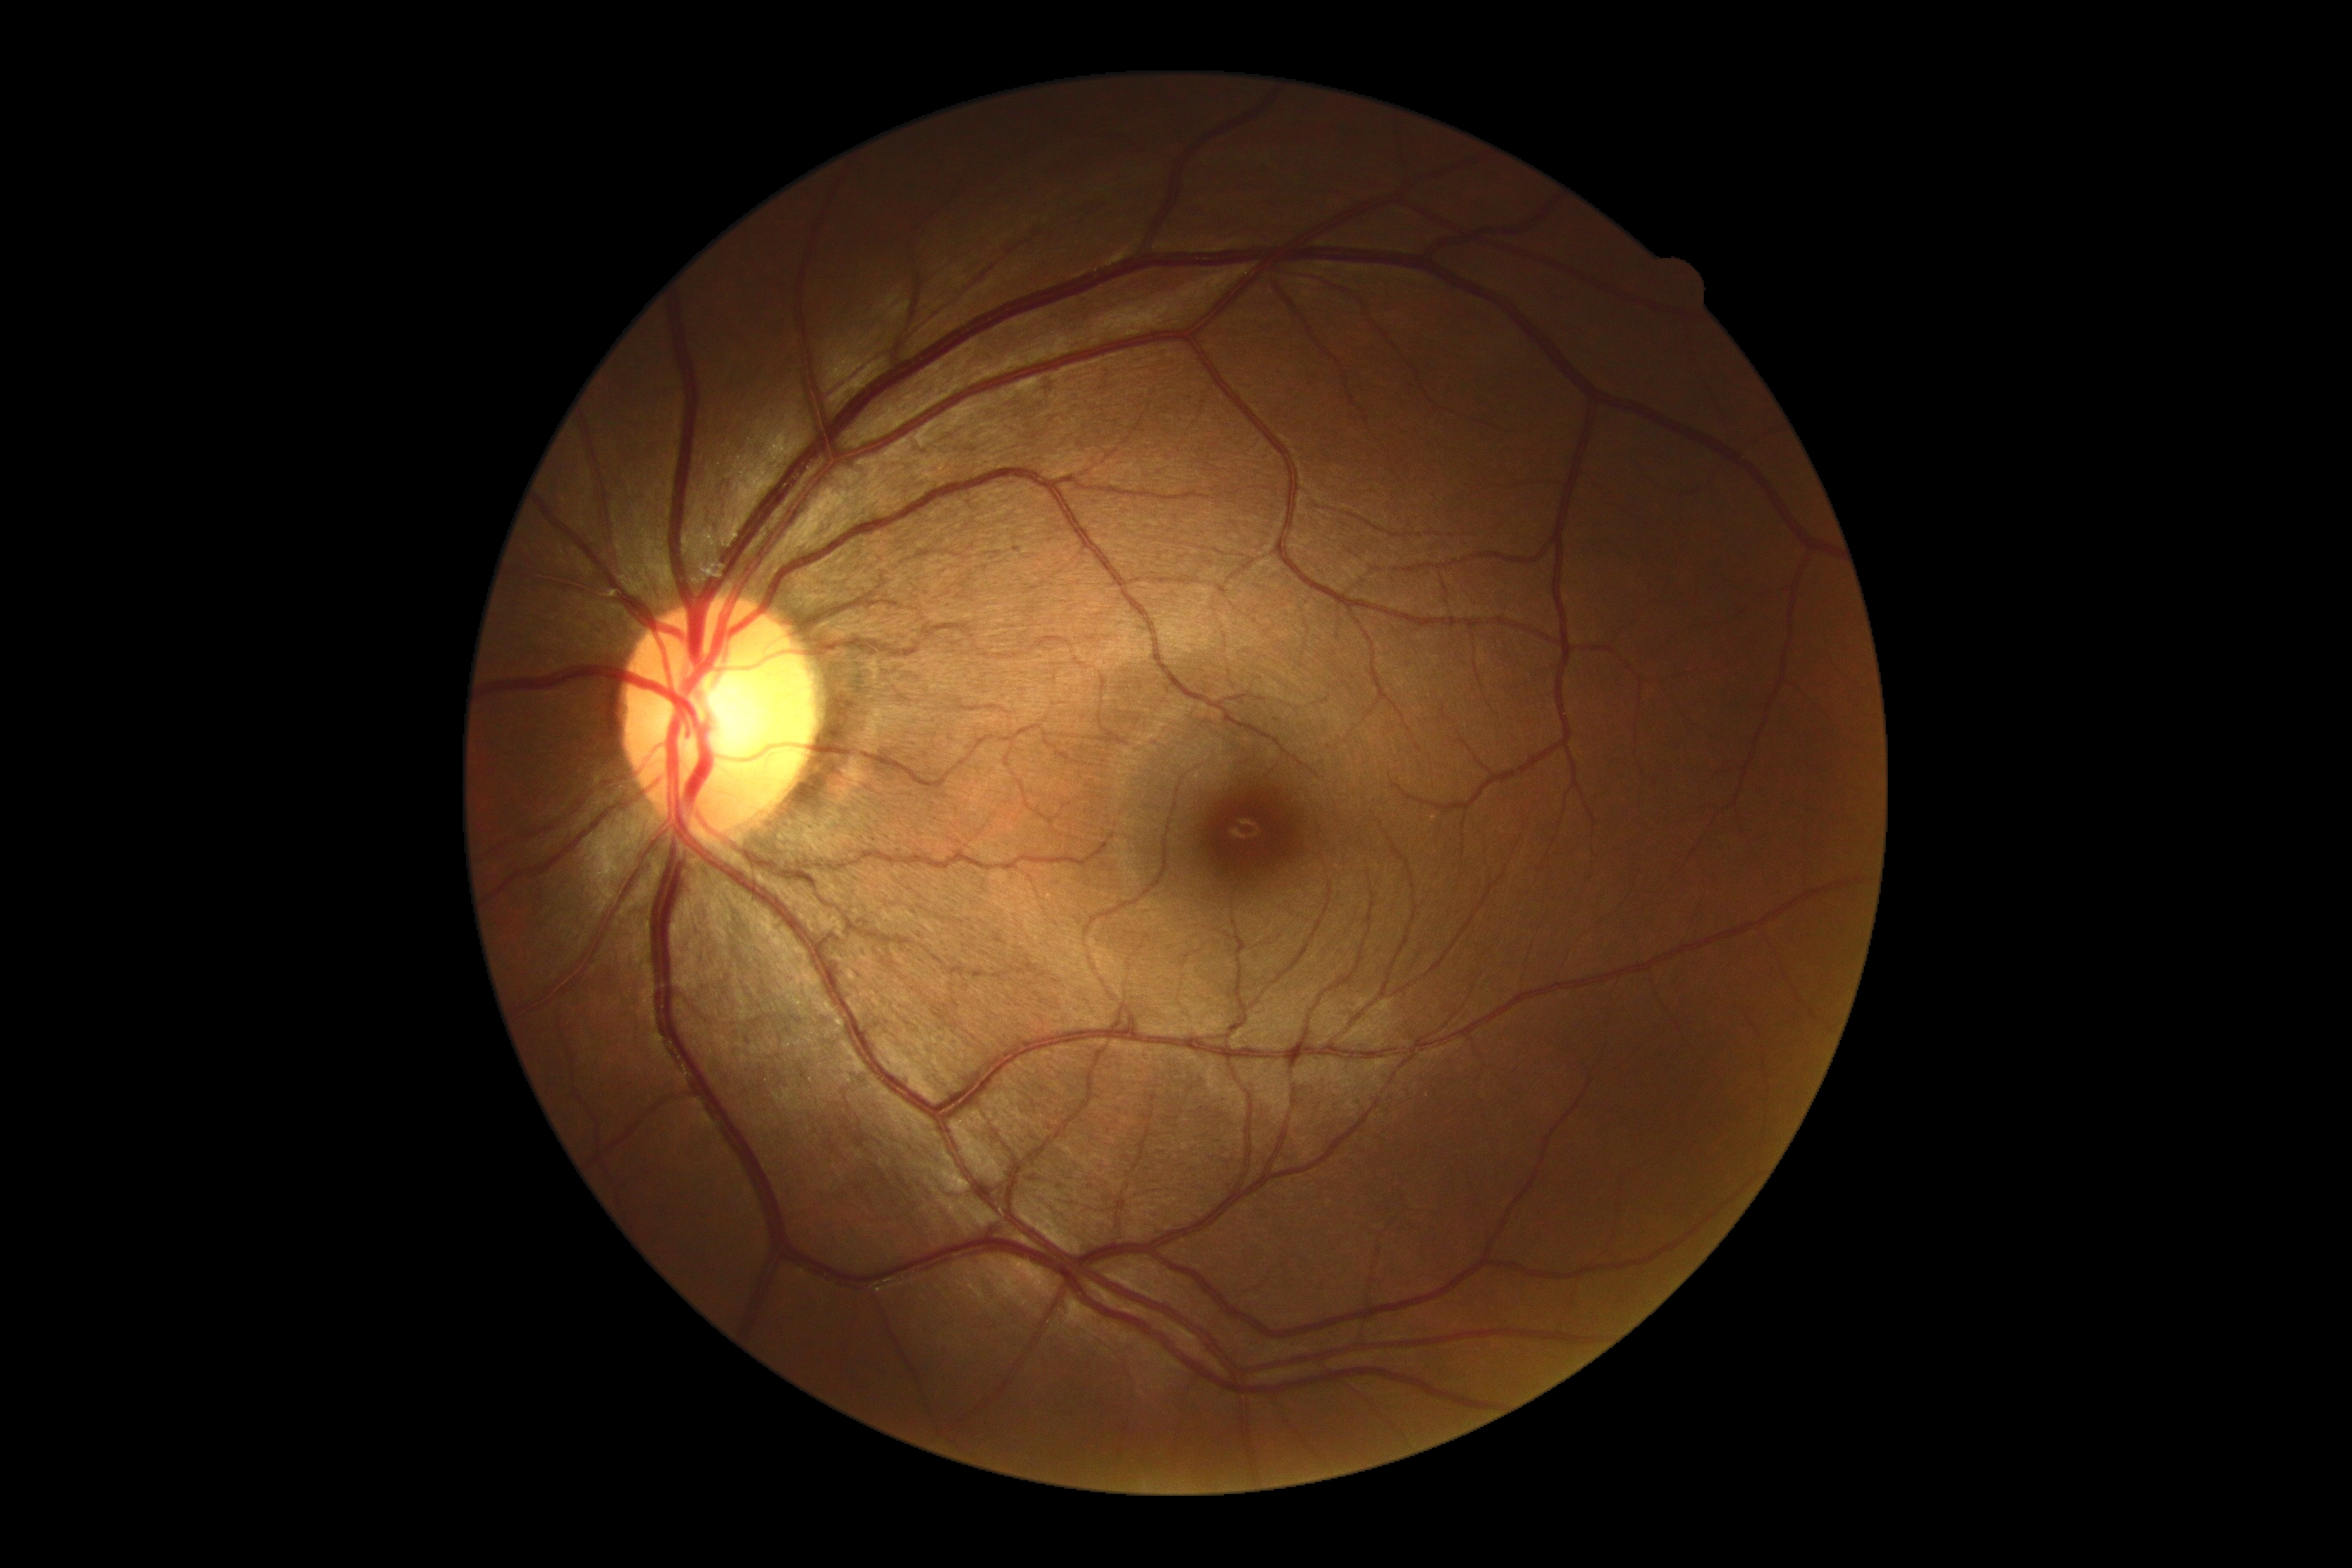

dr_grade: 0